Davis DR grading — 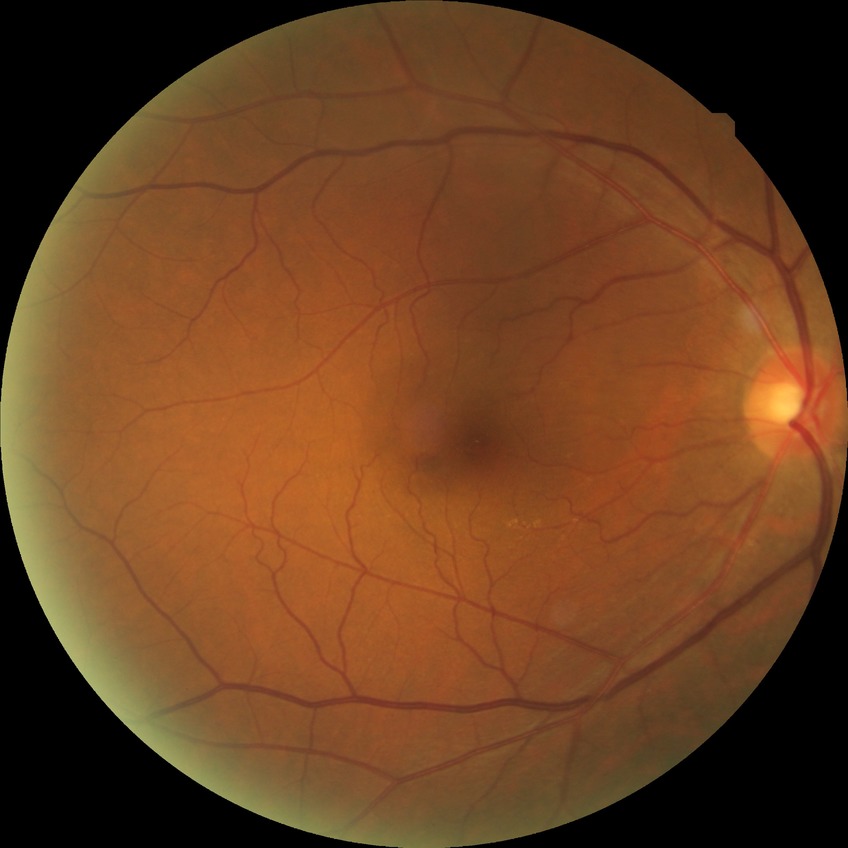

Davis grading: no diabetic retinopathy.